Fundus photo:
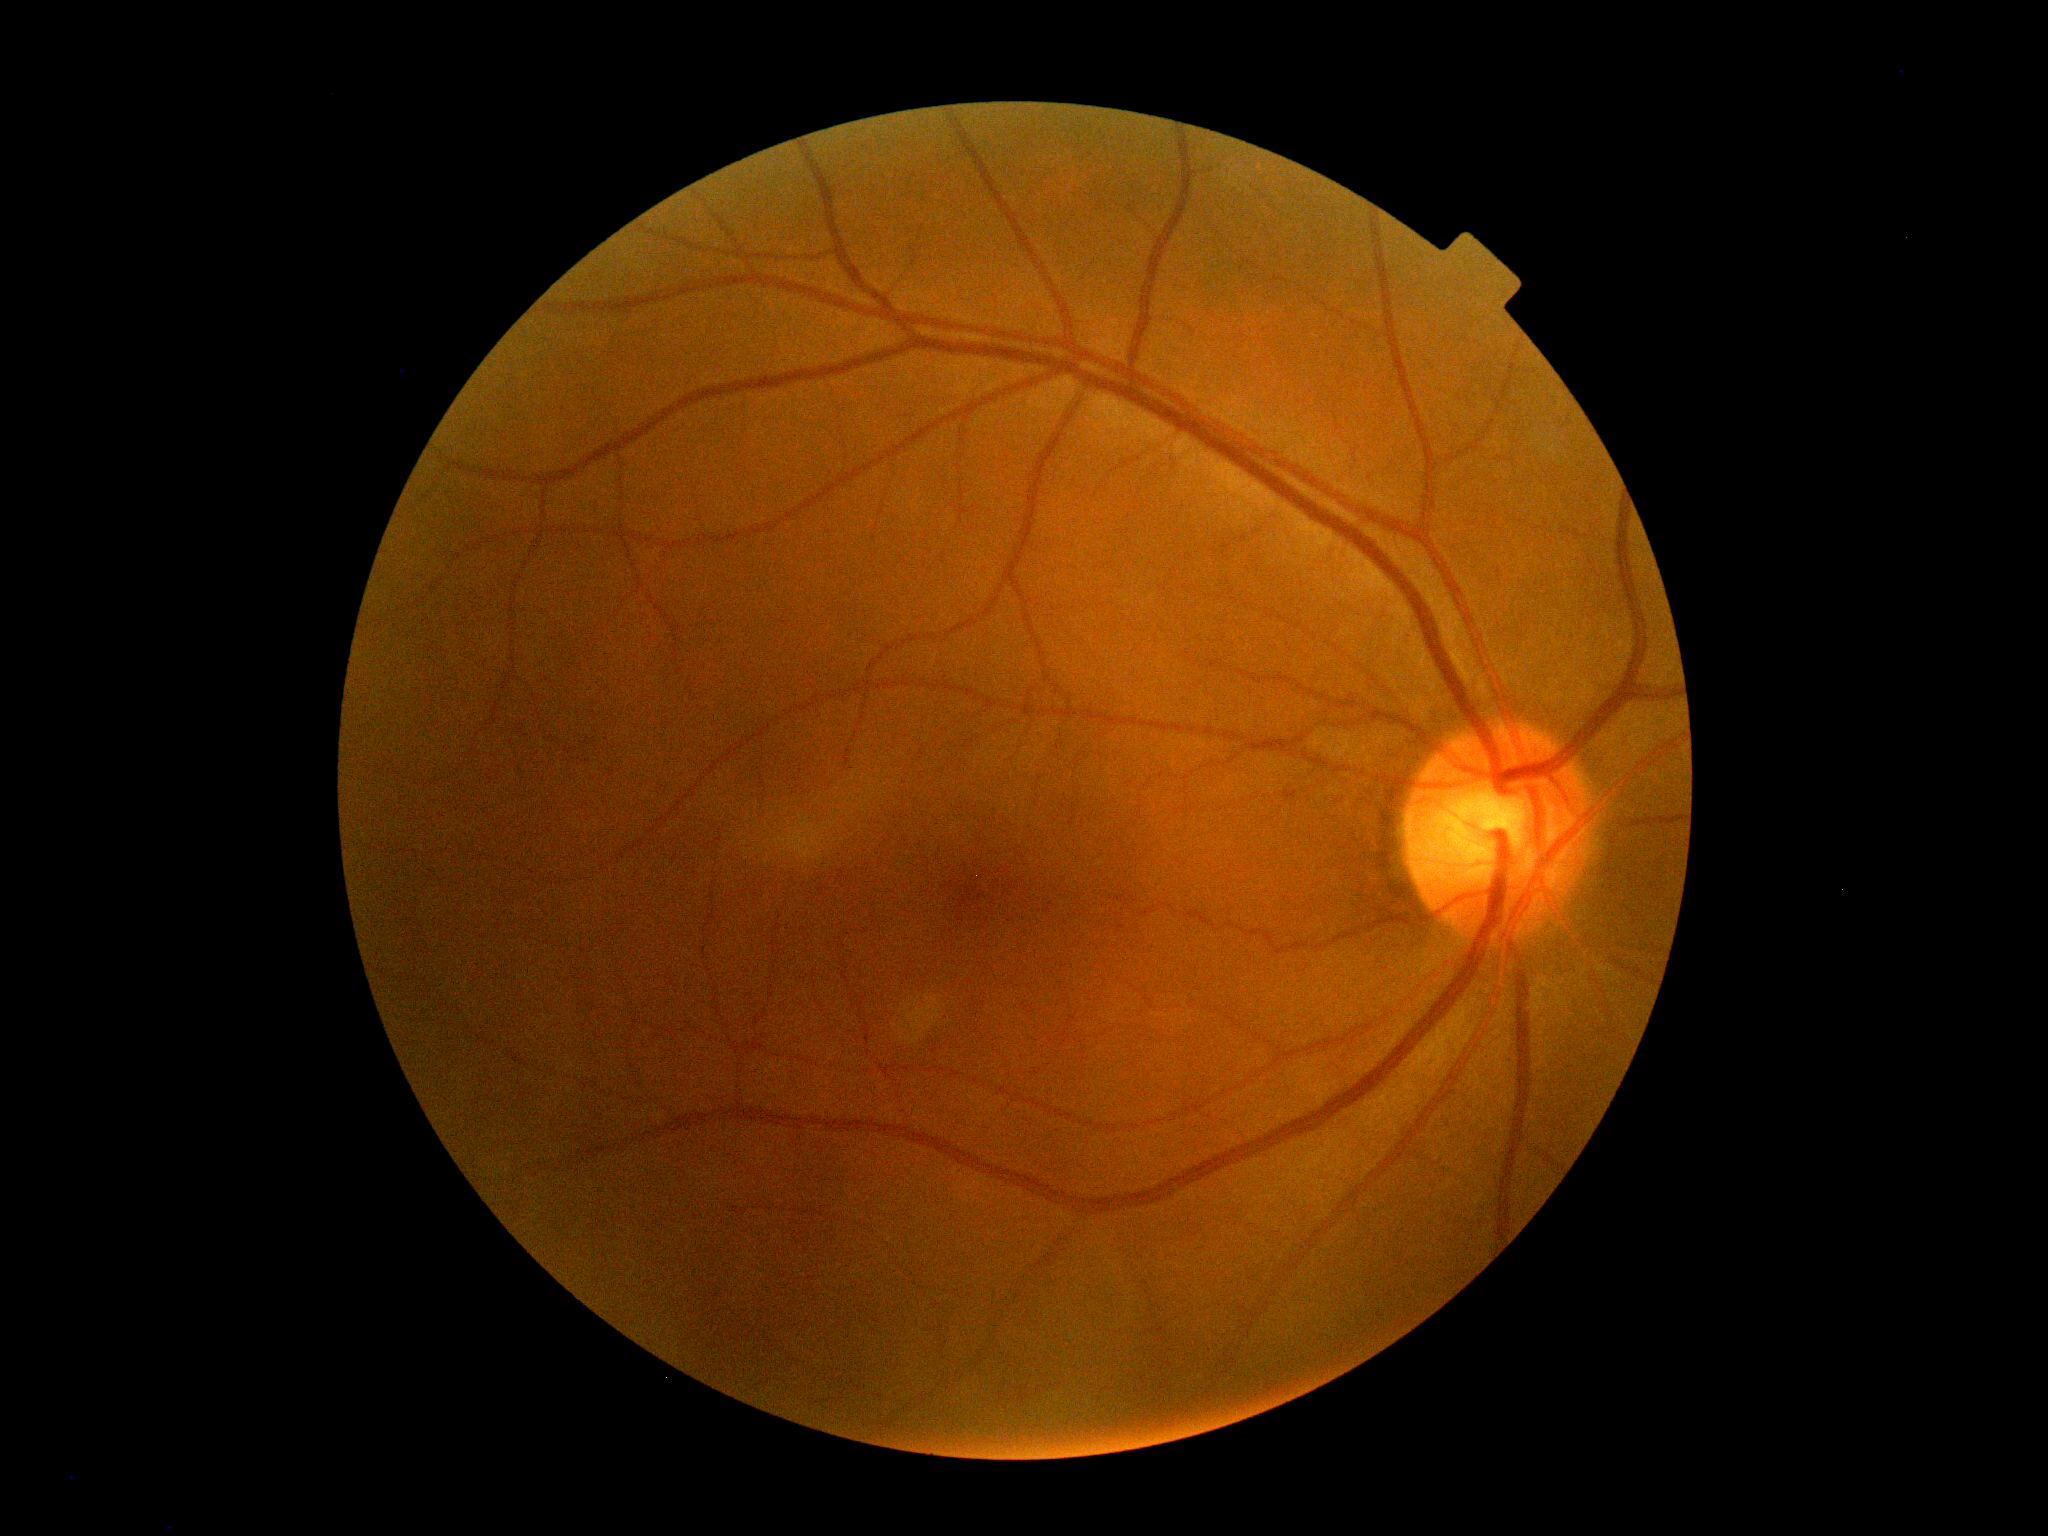 DR impression@no signs of DR, diabetic retinopathy (DR)@no apparent retinopathy (grade 0).